Captured on a Kowa VX-10α fundus camera — 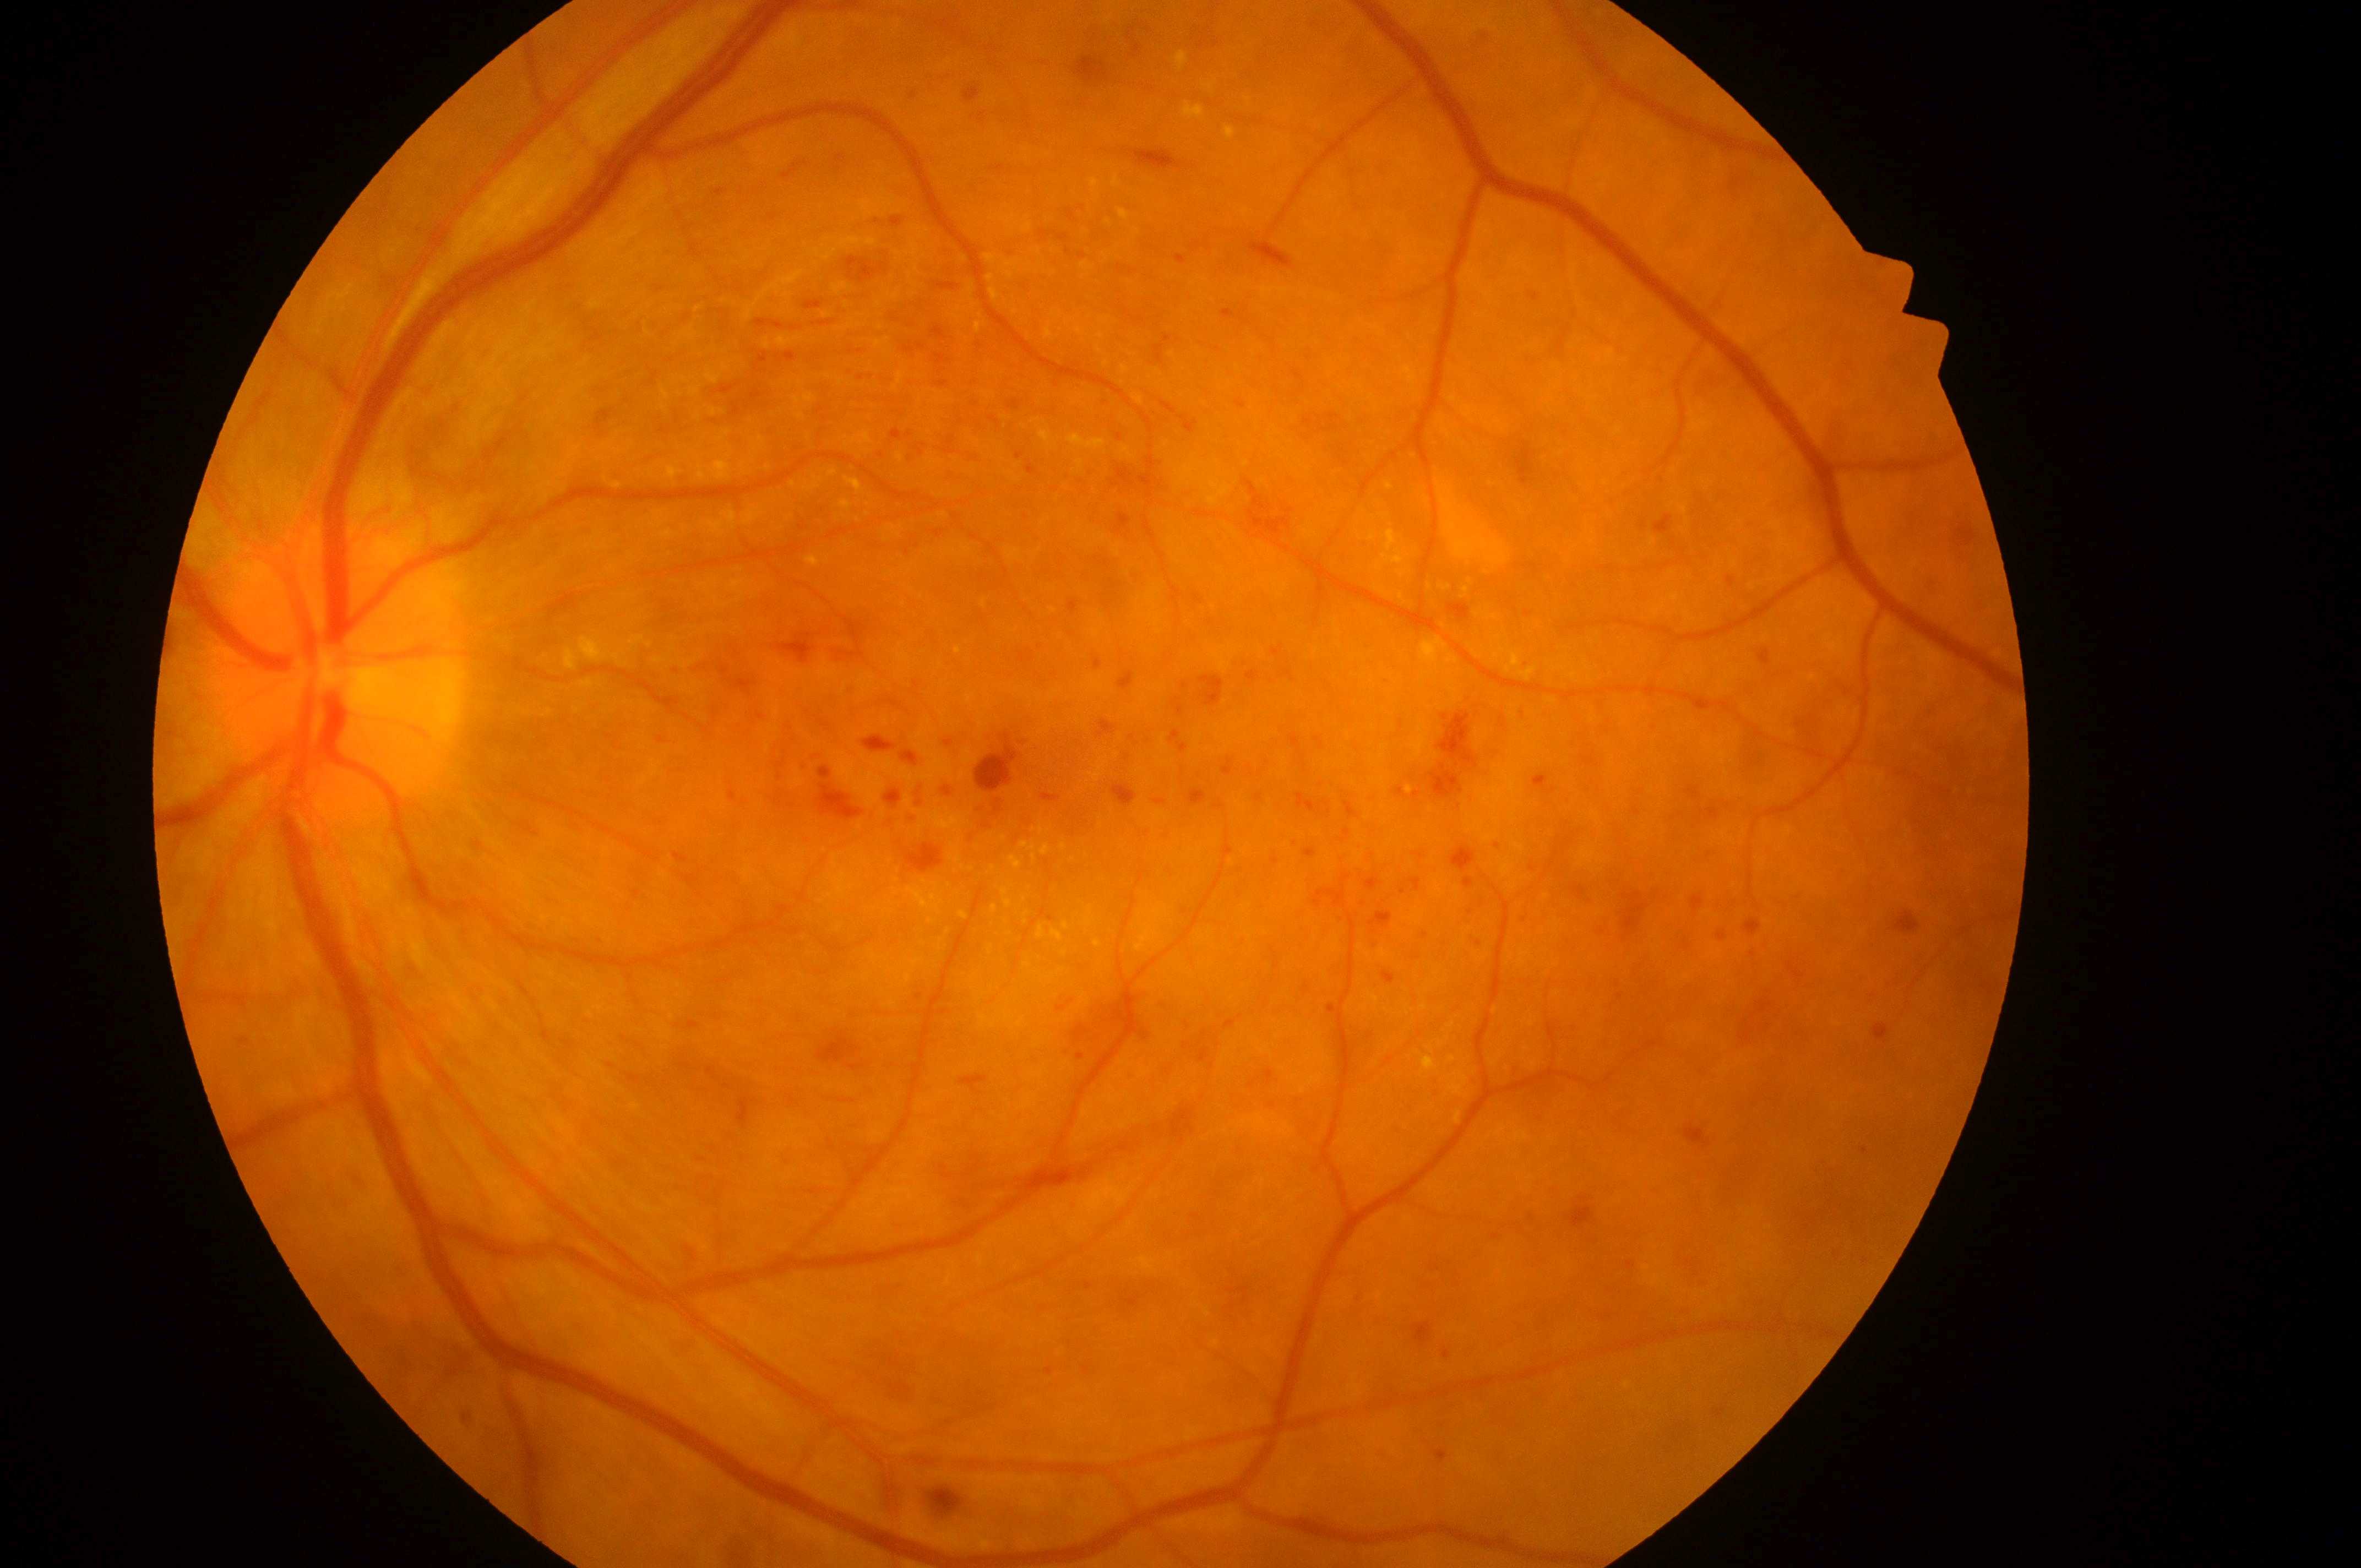
Optic disc center located at (x=338, y=682). DR class: non-proliferative diabetic retinopathy. The macula center is at (x=1033, y=765). DR grade is 3. The image shows the OS. DME: 2/2.